CFP — 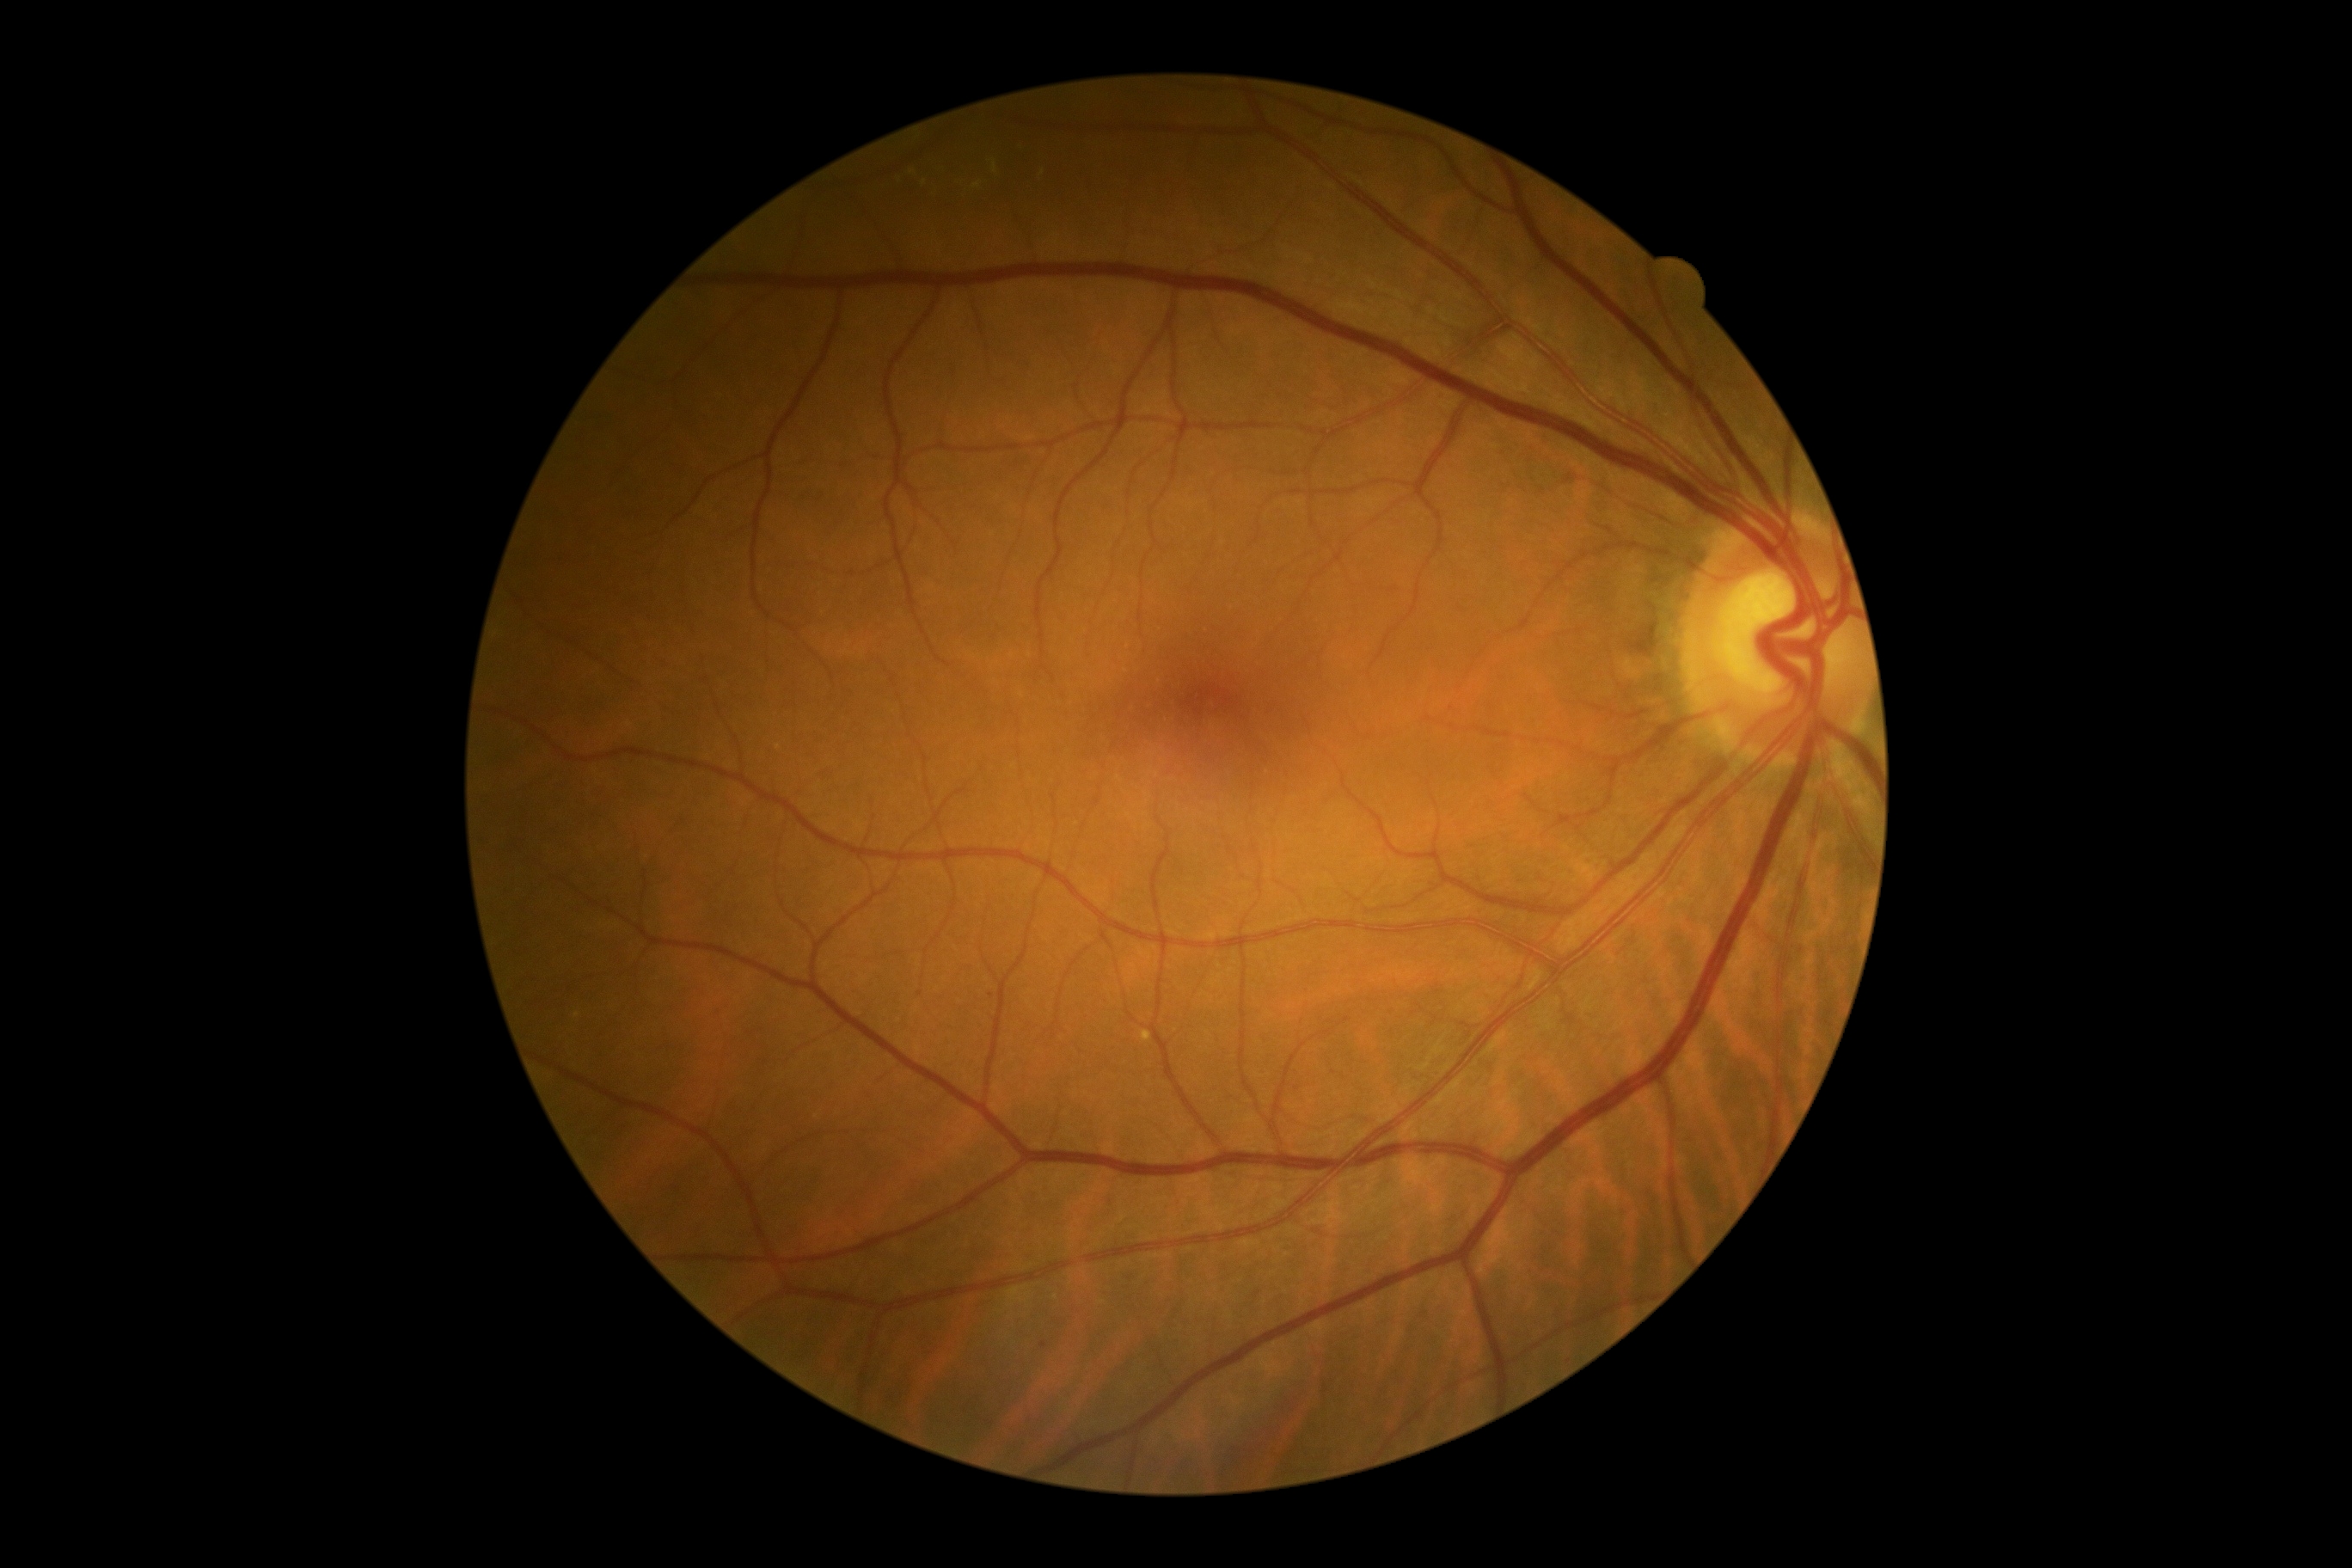
Diabetic retinopathy grade: 2 (moderate NPDR). DR class: non-proliferative diabetic retinopathy.